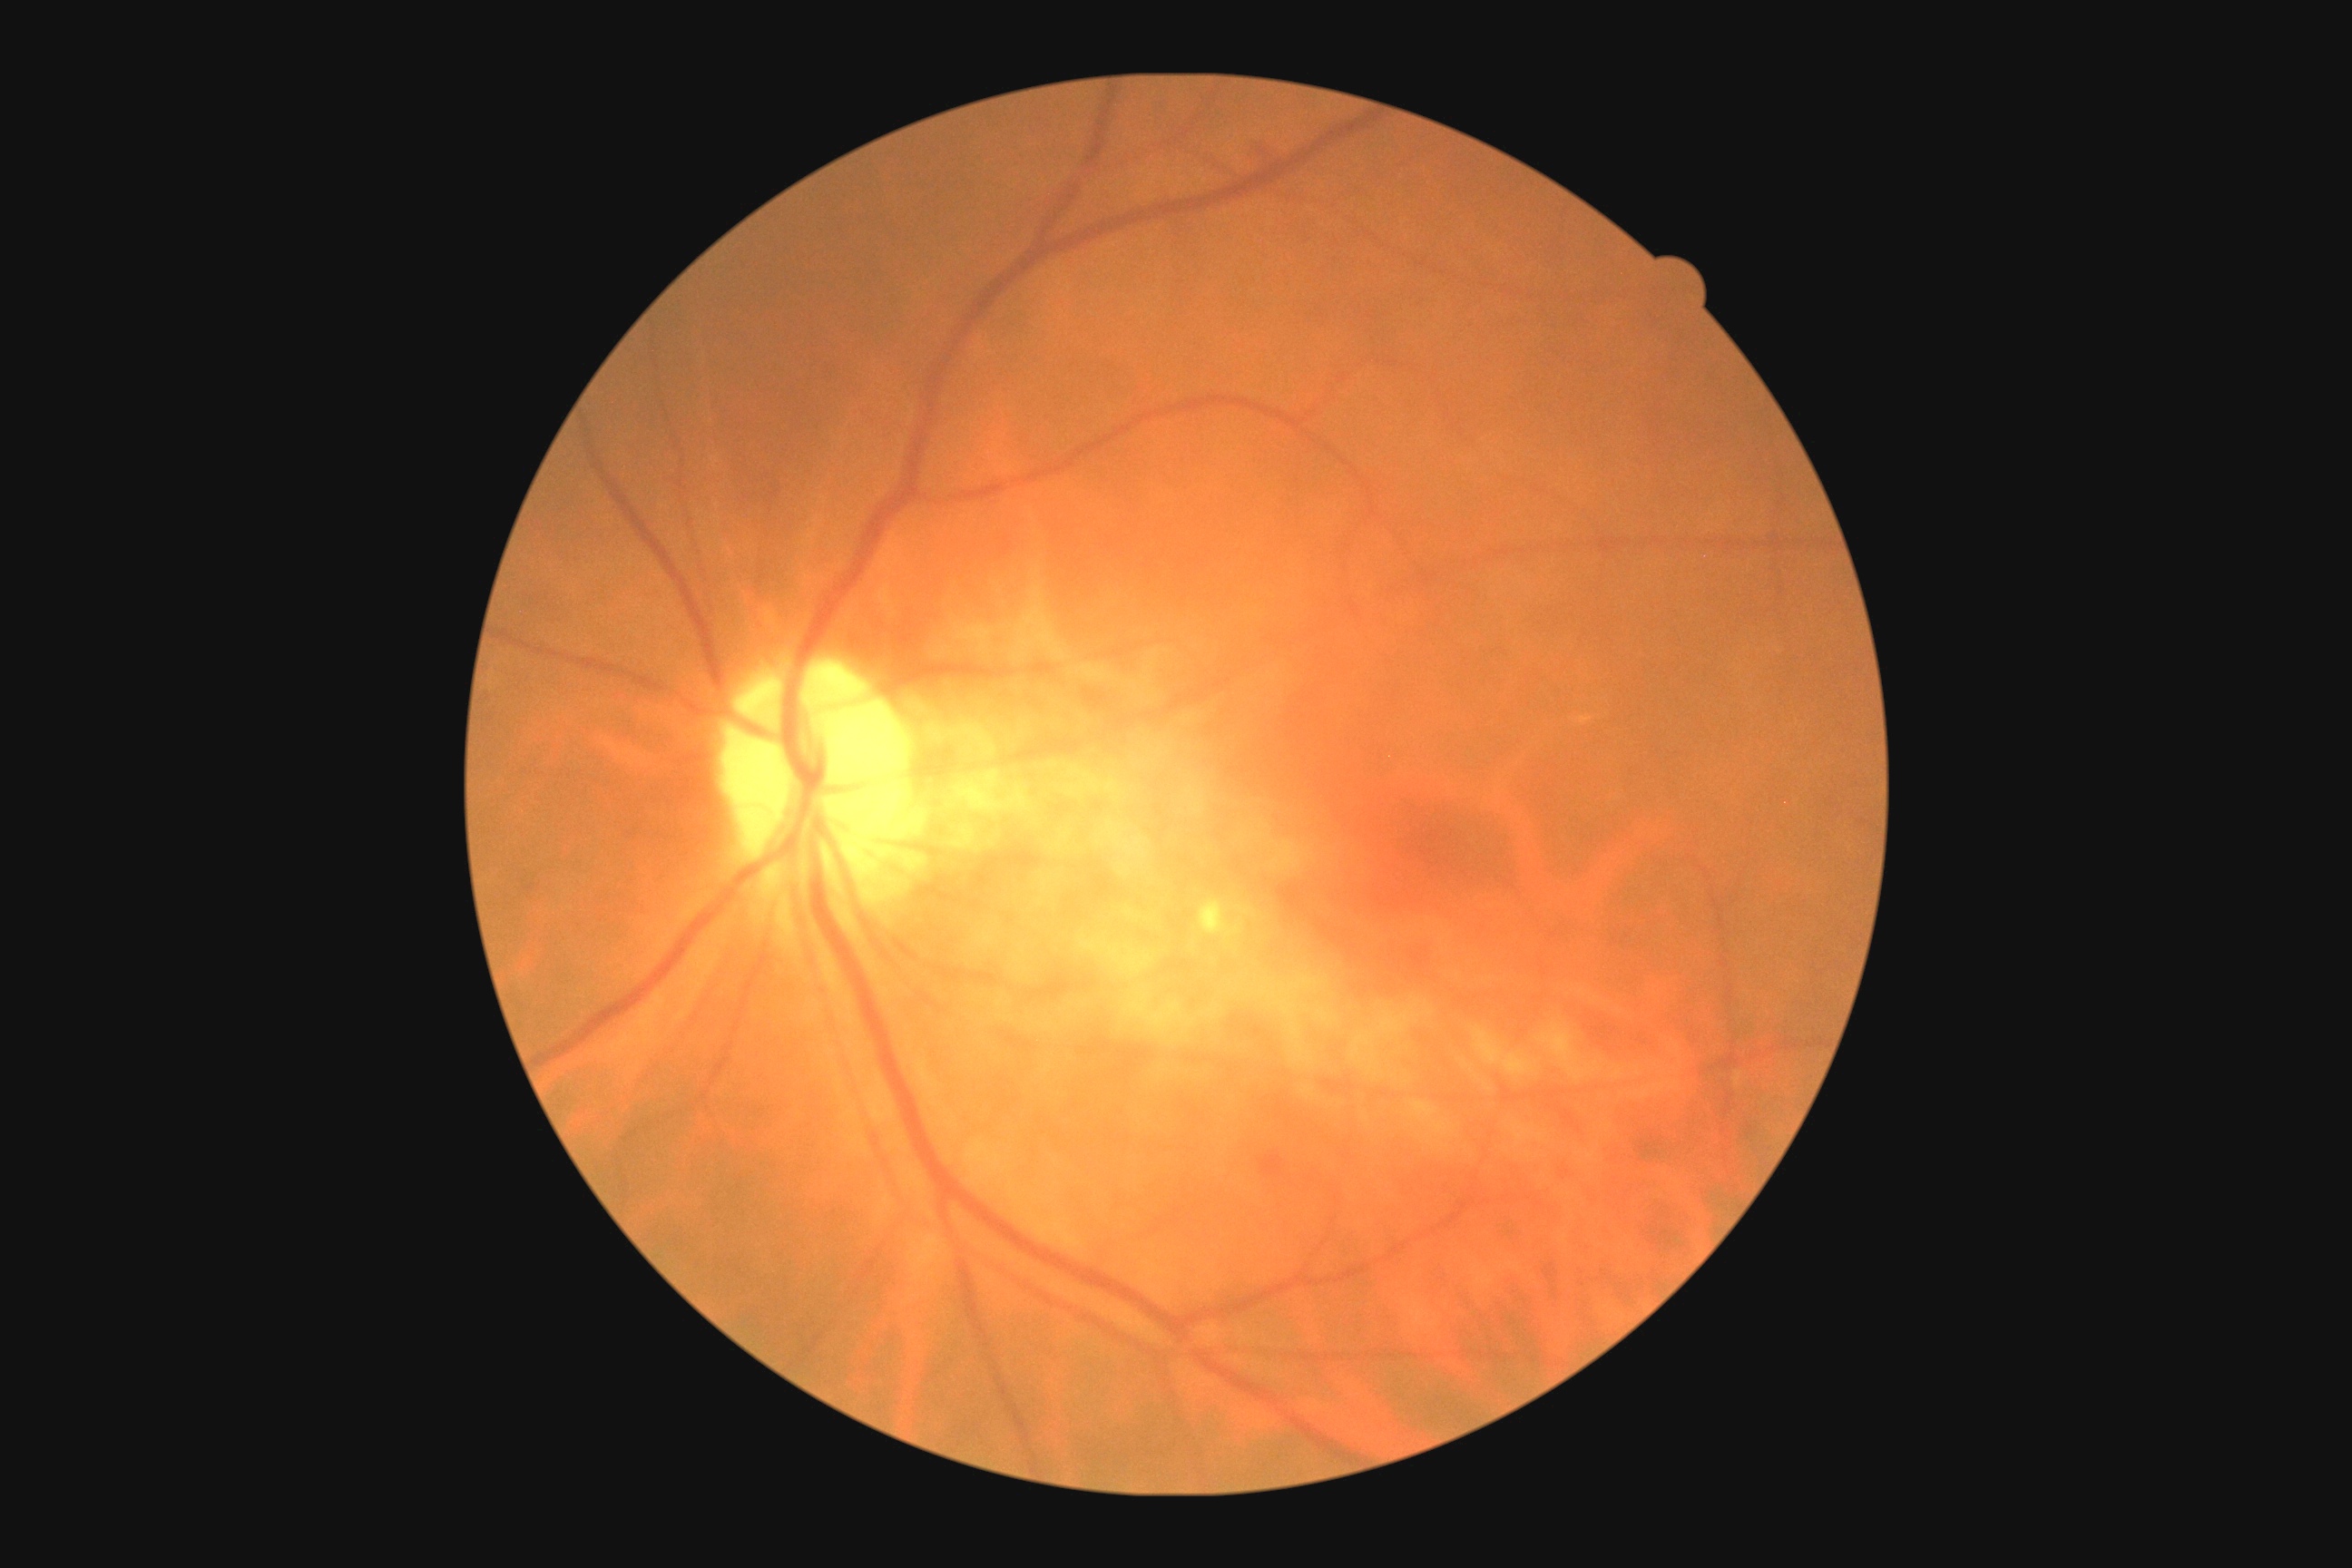

DR severity: moderate NPDR (grade 2).